848x848. Retinal fundus photograph. NIDEK AFC-230. FOV: 45 degrees. Nonmydriatic fundus photograph.
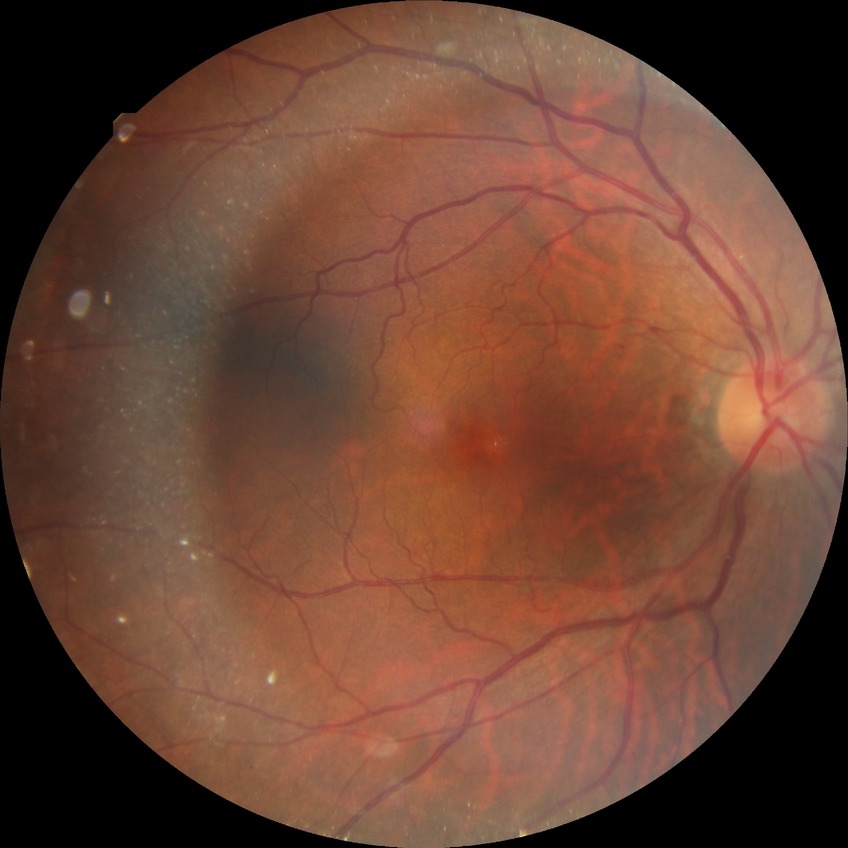

* Davis grading — simple diabetic retinopathy